Davis DR grading · posterior pole photograph · 848x848px
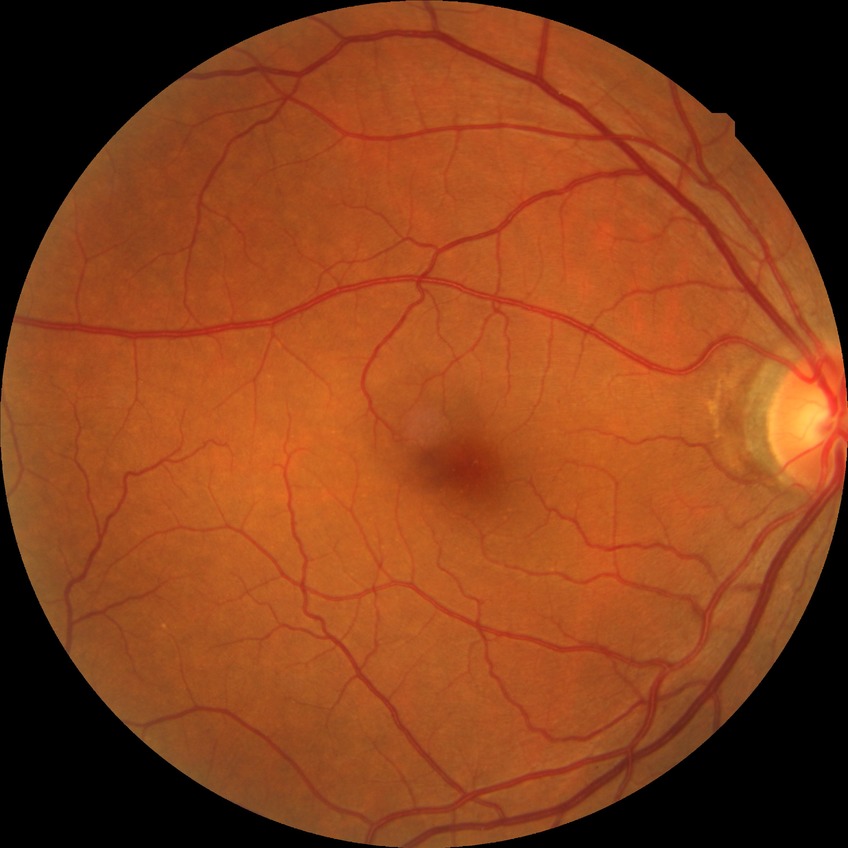
Assessment:
• diabetic retinopathy (DR): NDR (no diabetic retinopathy)